2048 x 1536 pixels.
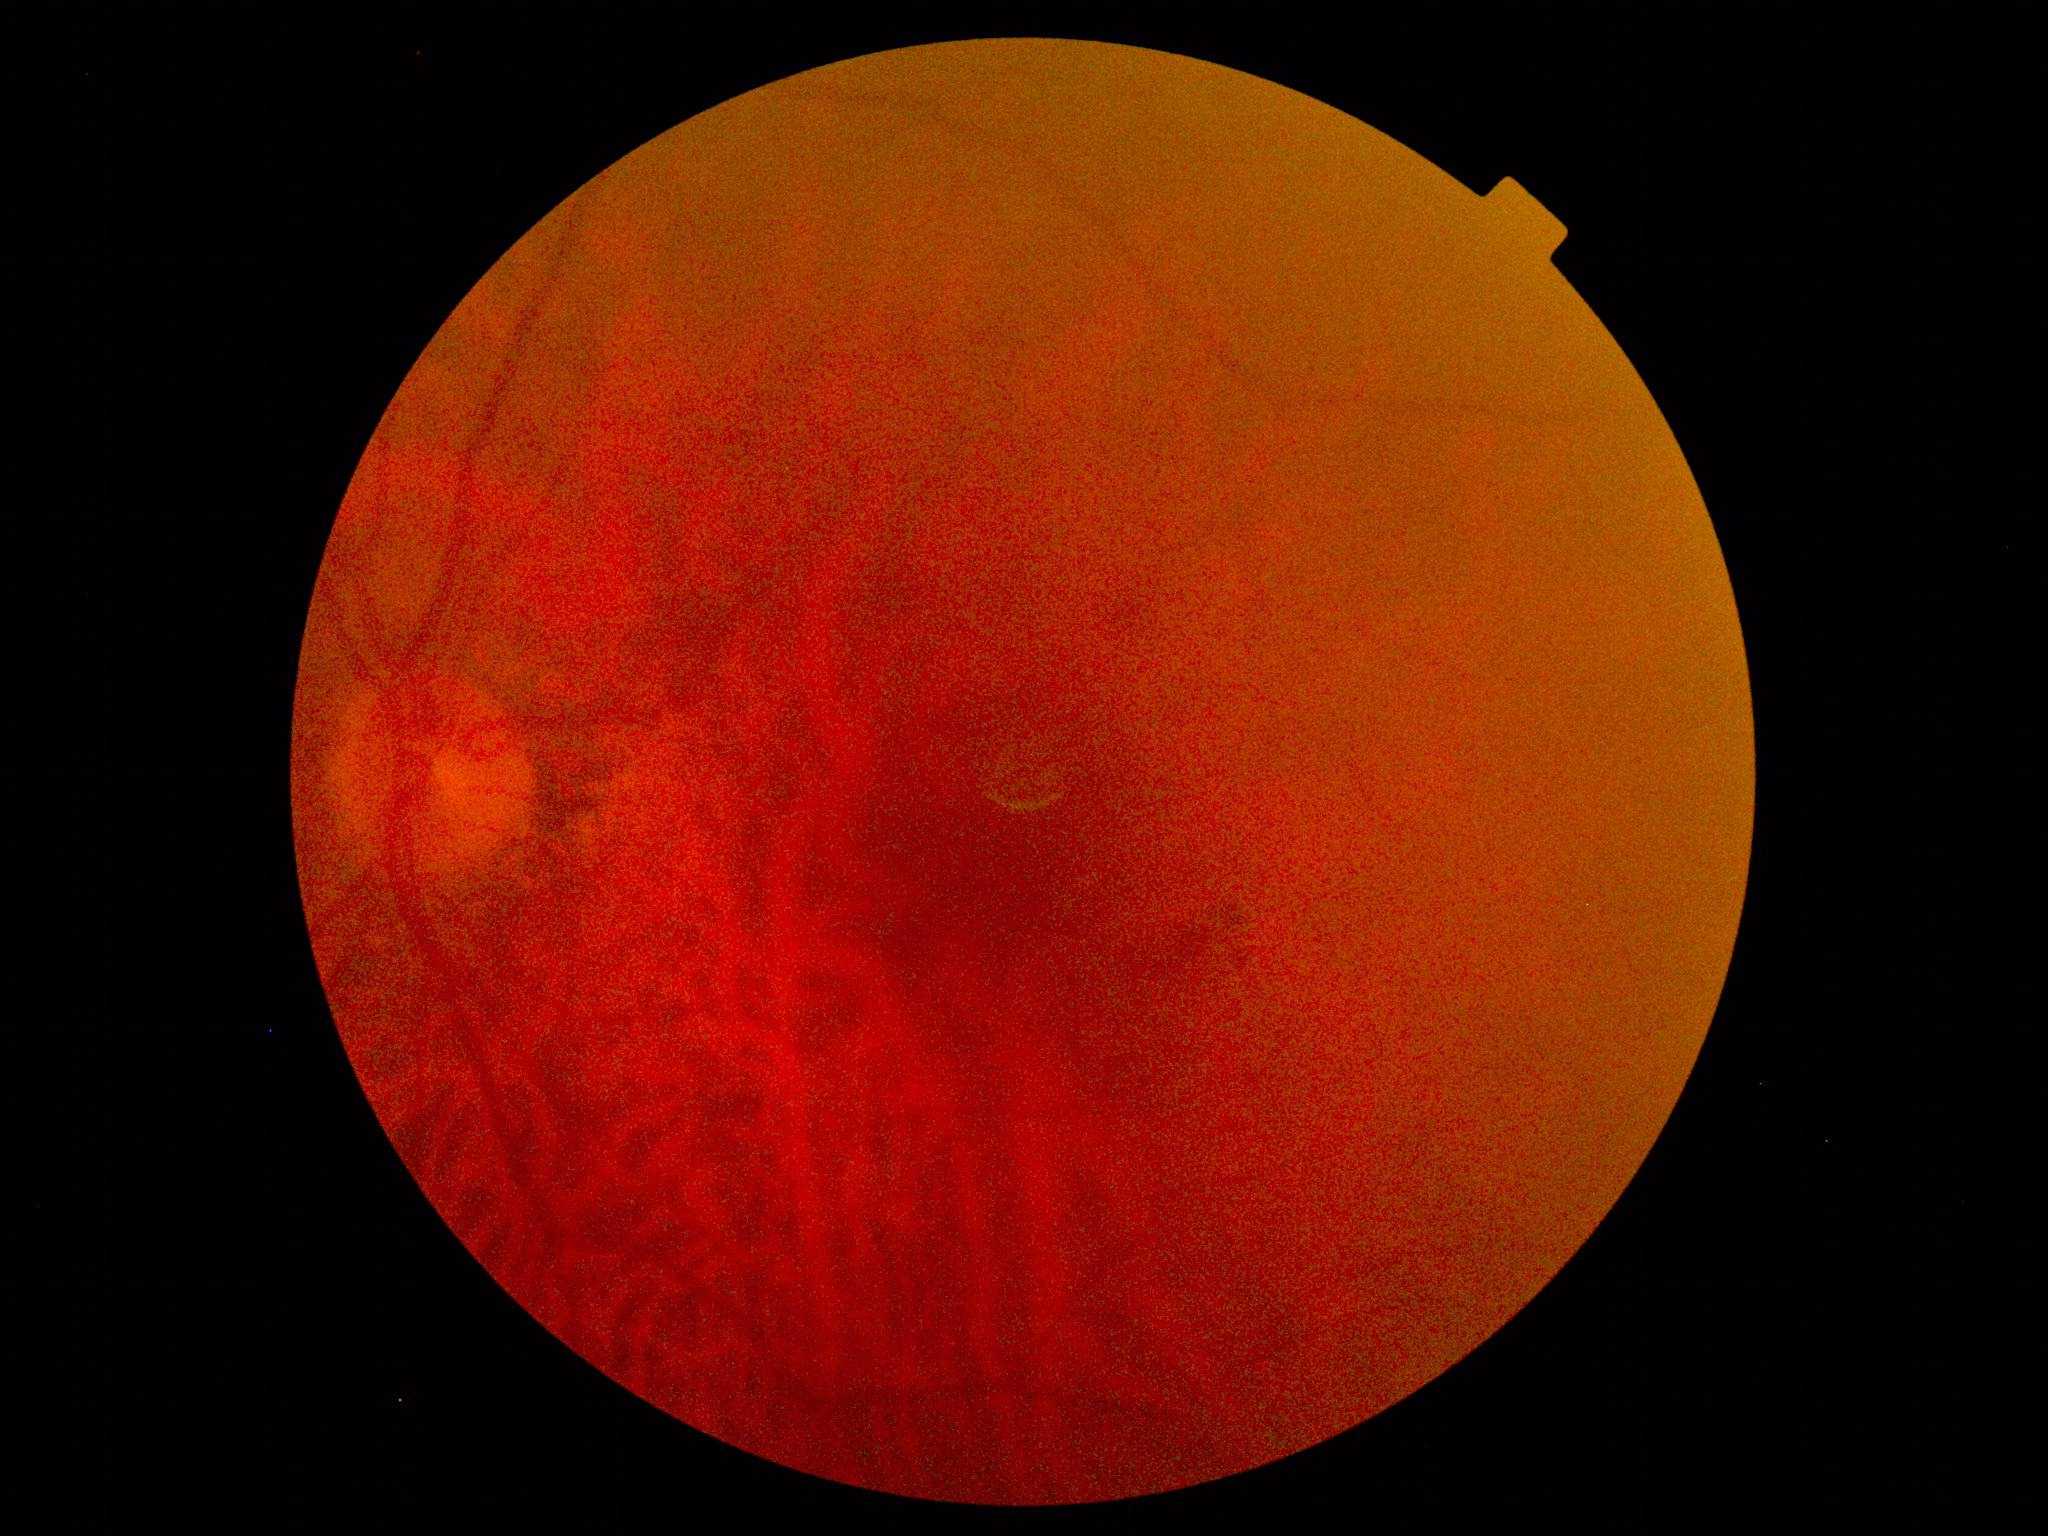

DR is moderate non-proliferative diabetic retinopathy (grade 2).
DR class: non-proliferative diabetic retinopathy.